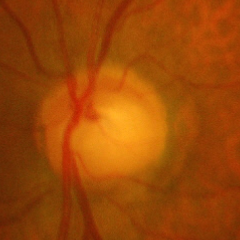 Advanced-stage glaucoma.
Diagnostic criteria: near-total cupping of the optic nerve head, with or without severe visual field loss within the central 10 degrees of fixation.